Nonmydriatic · retinal fundus photograph · 45° field of view · 848 by 848 pixels:
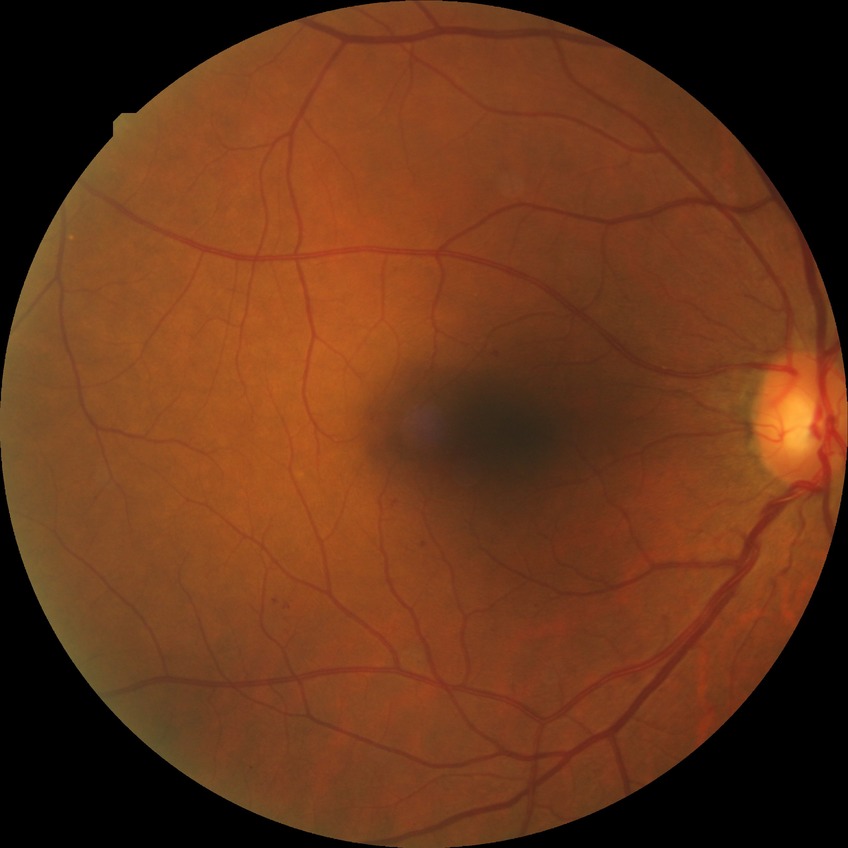
  davis_grade: SDR